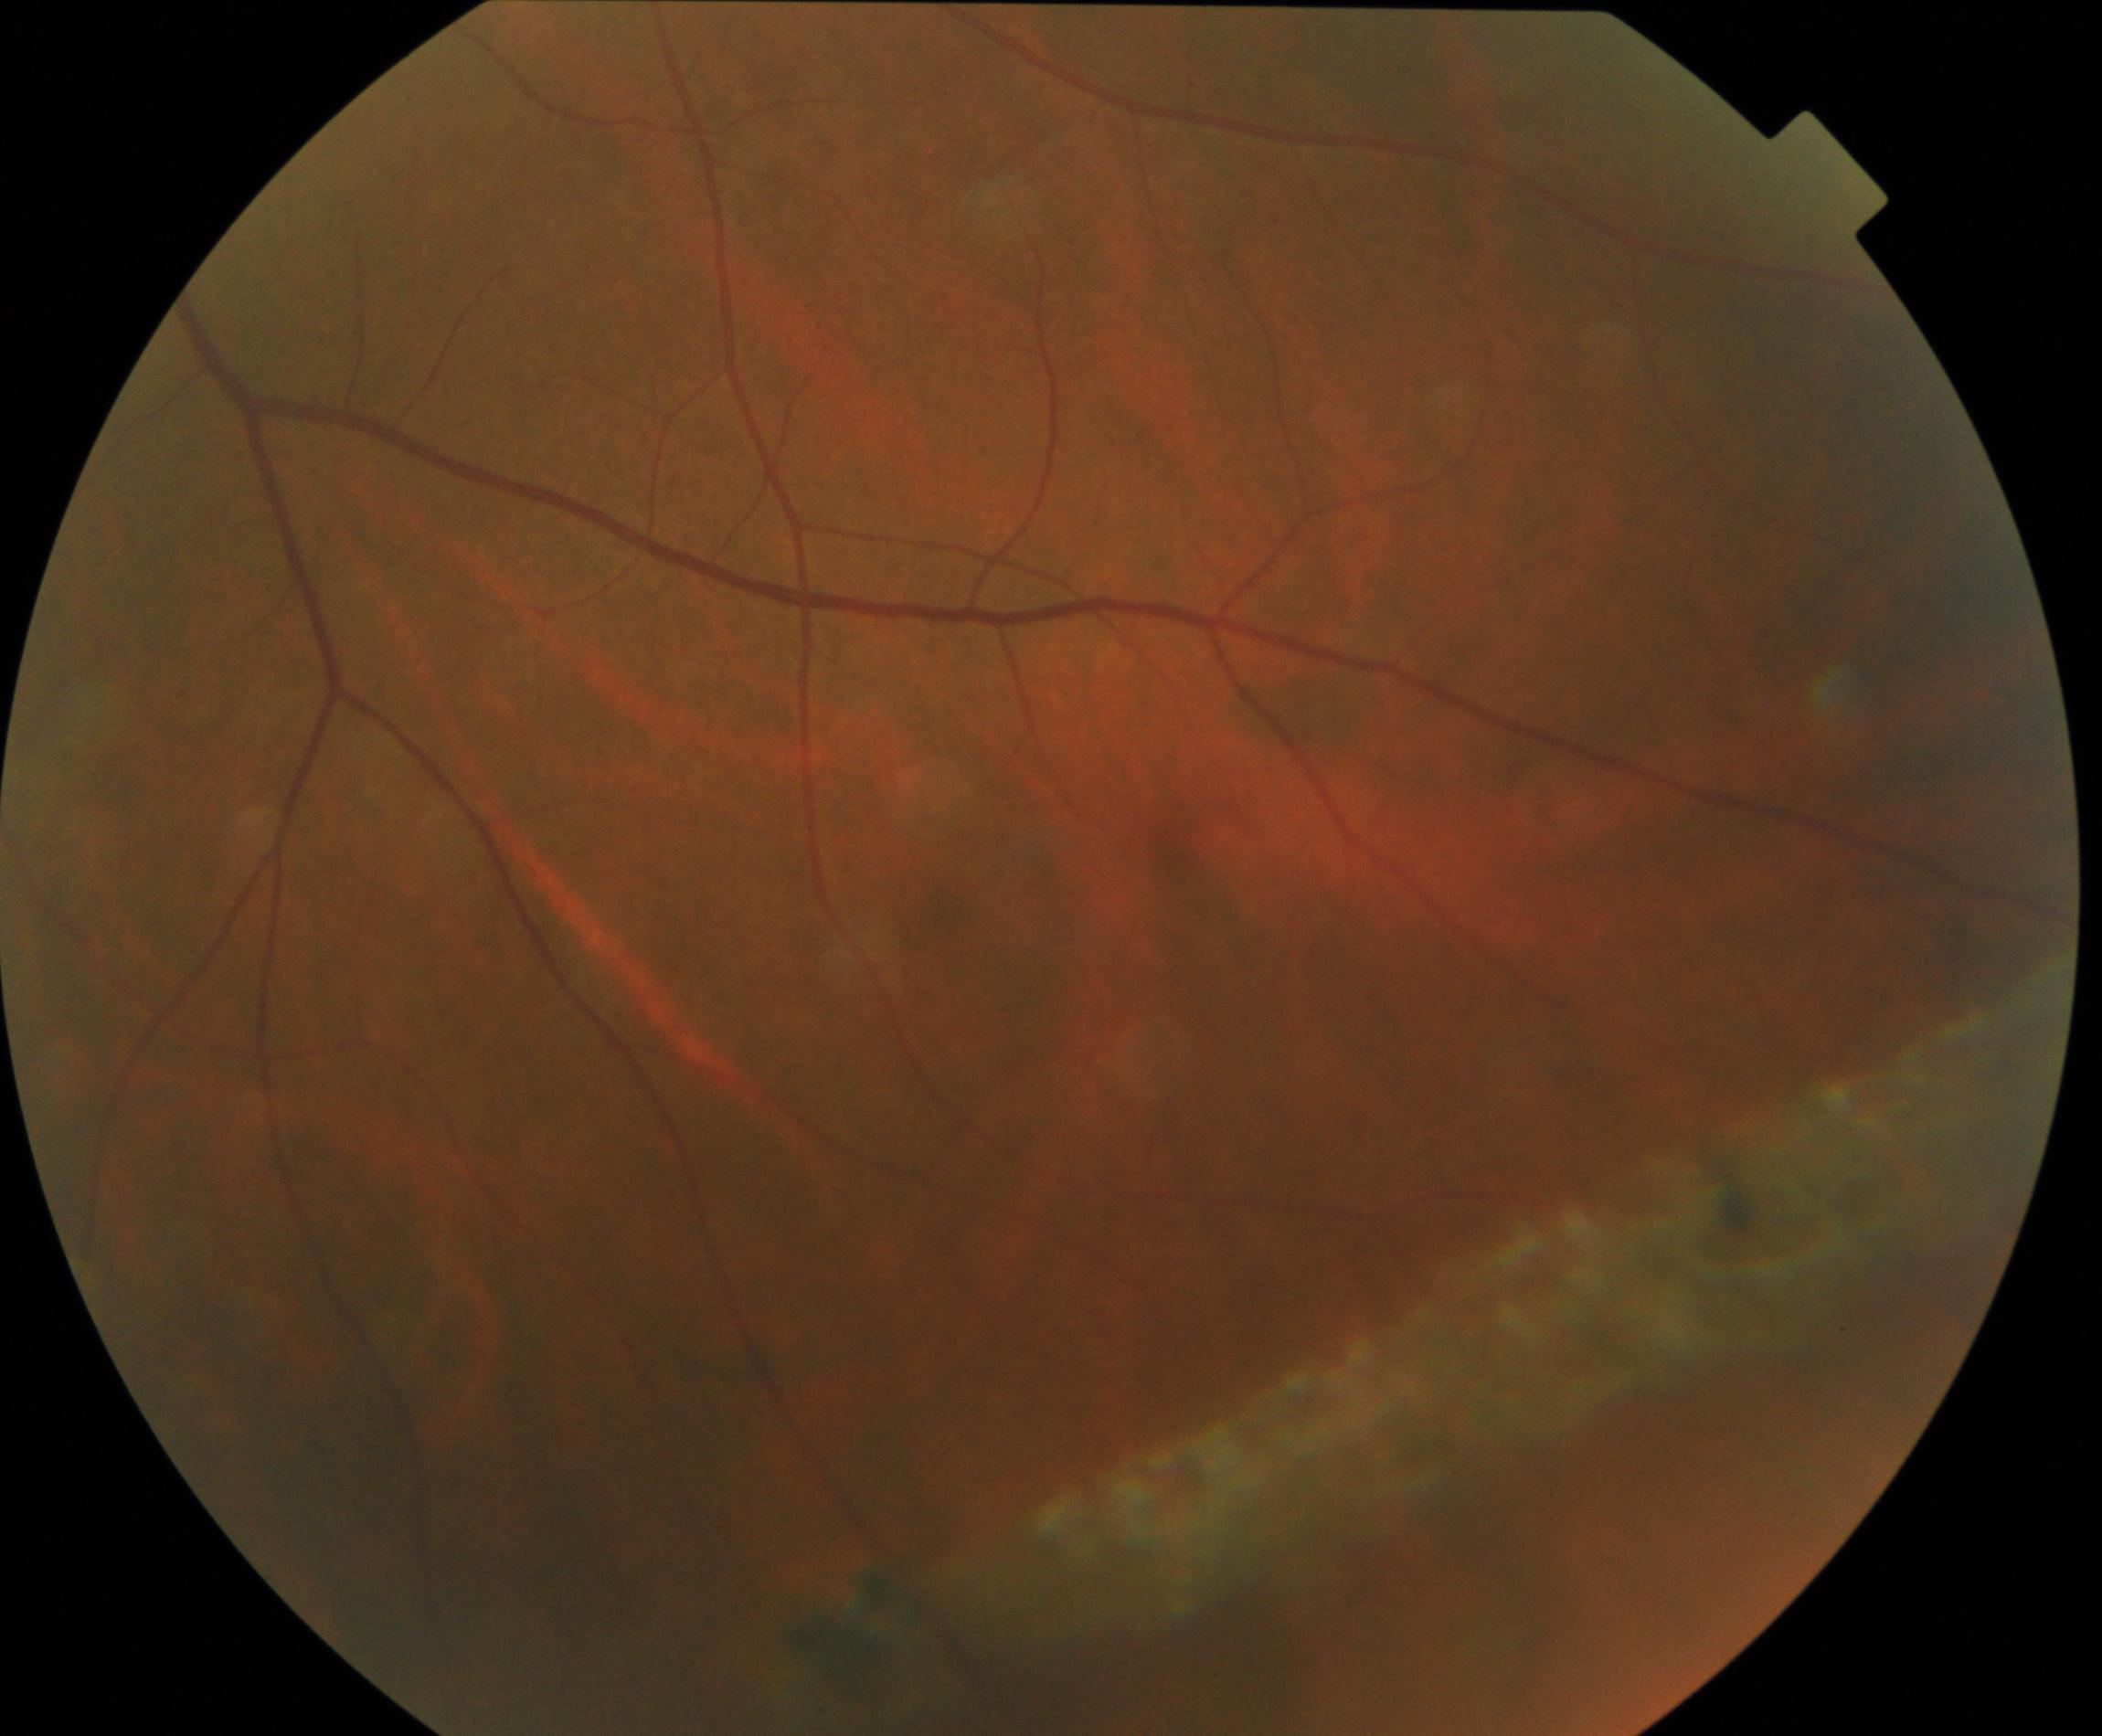
Diagnosis: peripheral retinal degeneration and break.